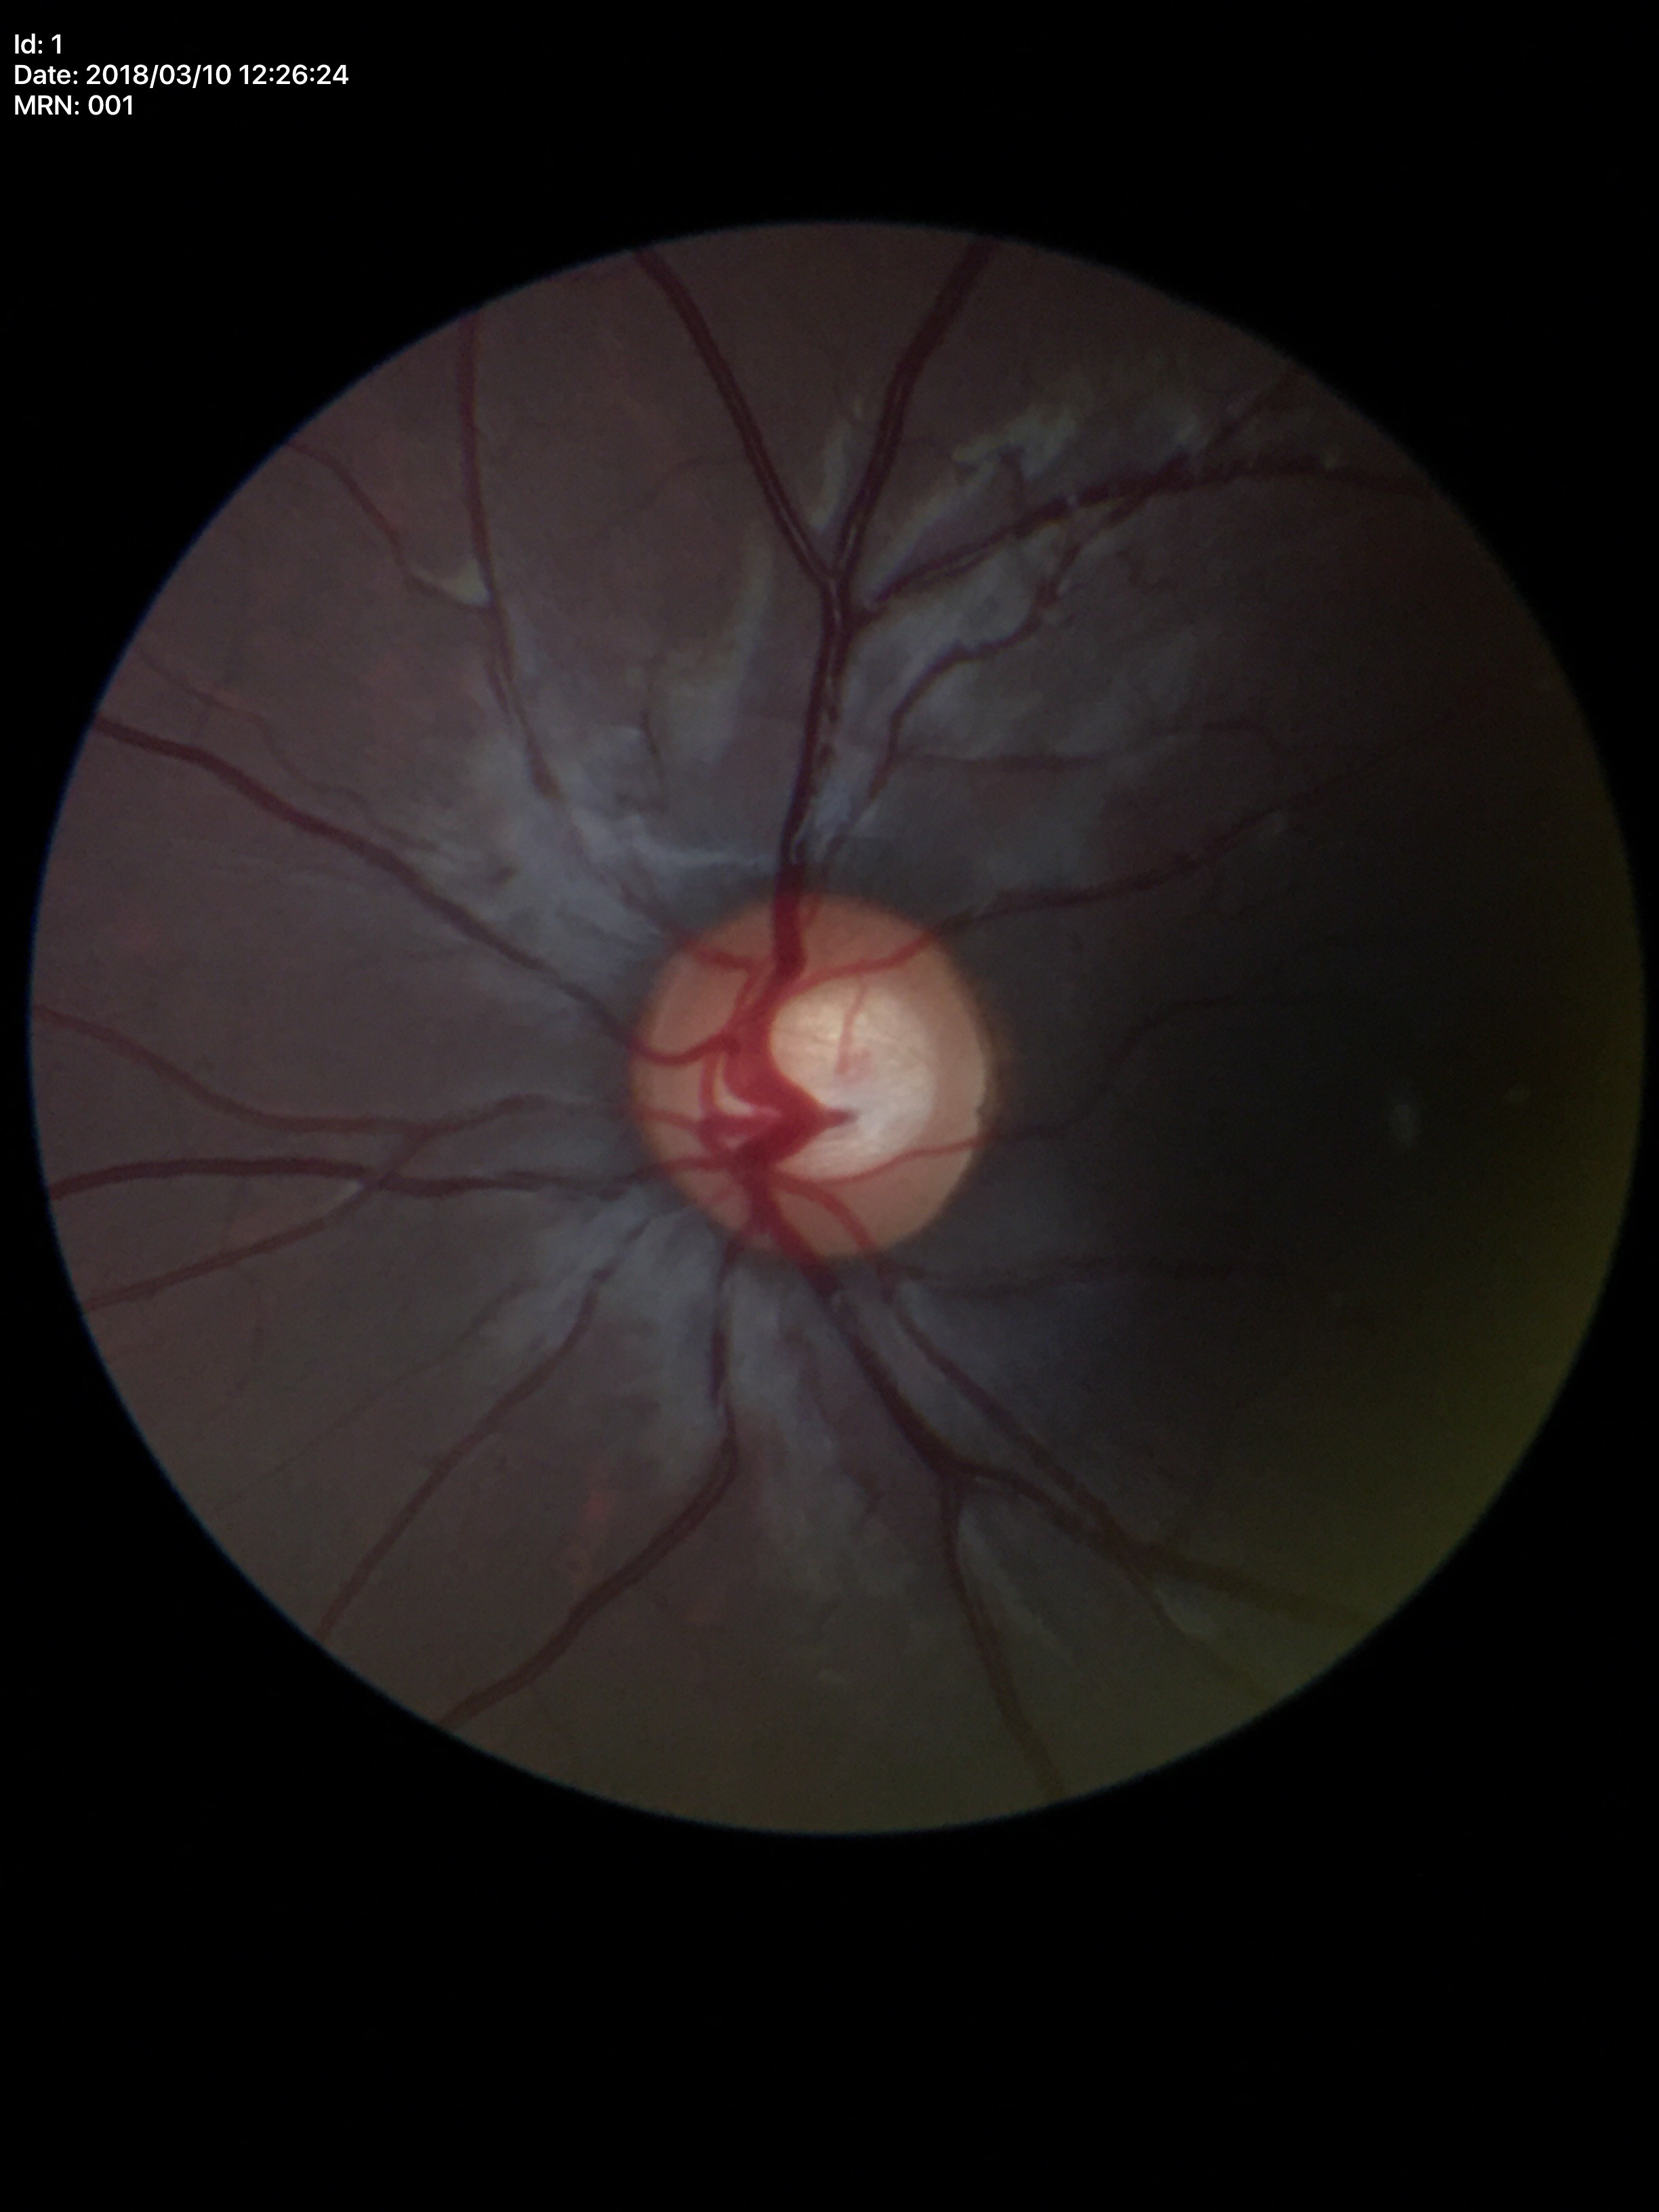 Glaucoma suspect.
VCDR: 0.59.